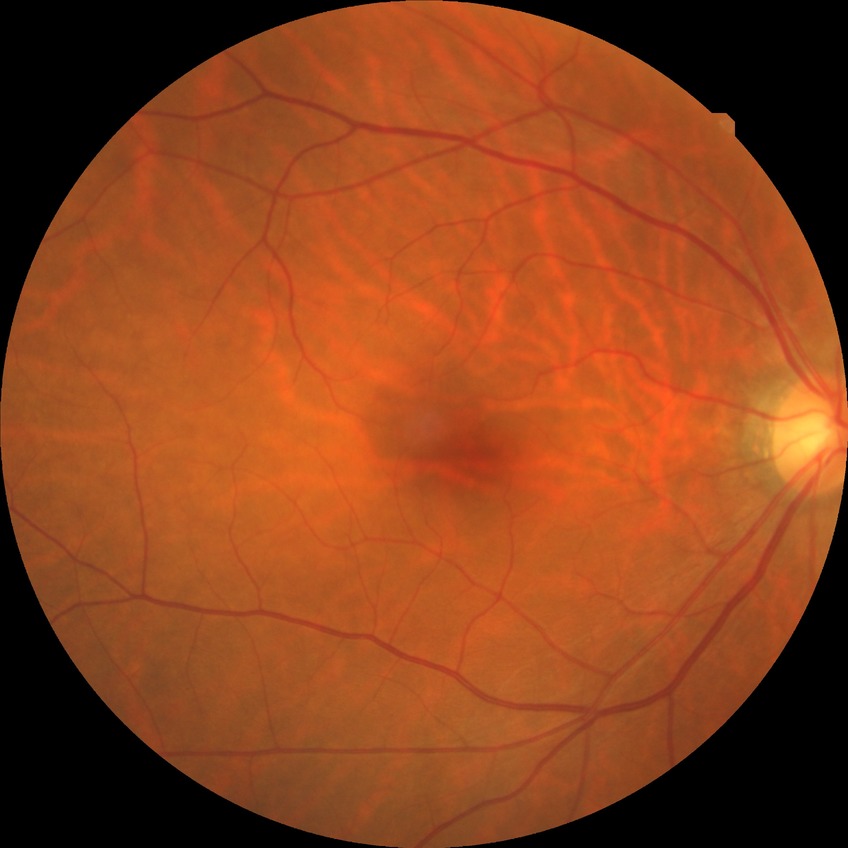 diabetic retinopathy (DR)@NDR (no diabetic retinopathy).